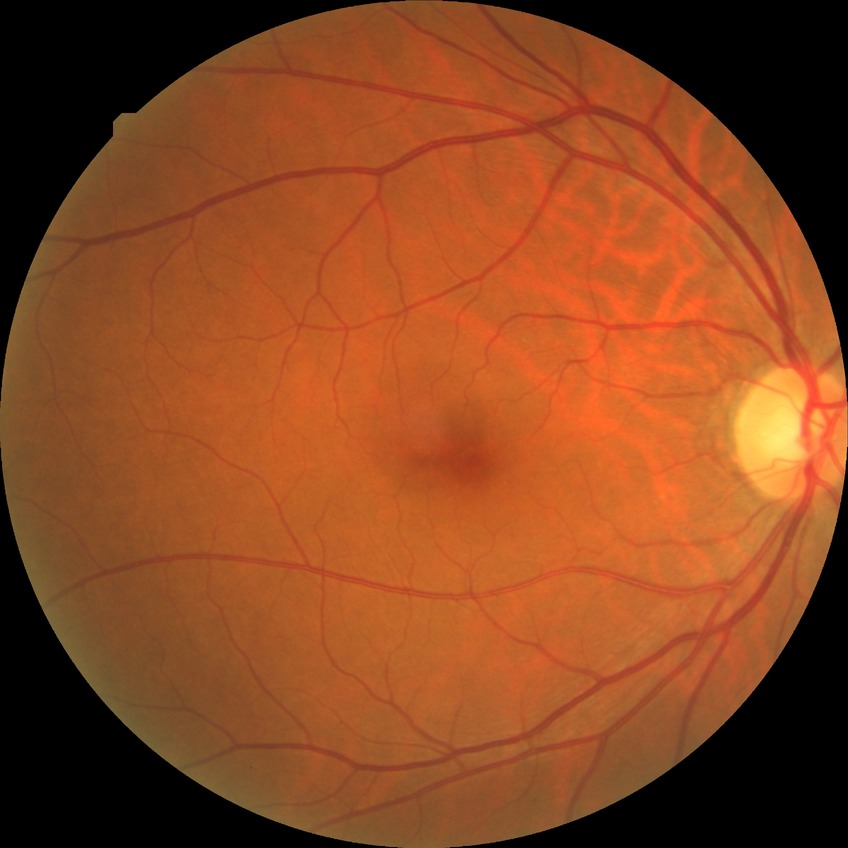

diabetic retinopathy (DR)=no diabetic retinopathy (NDR).